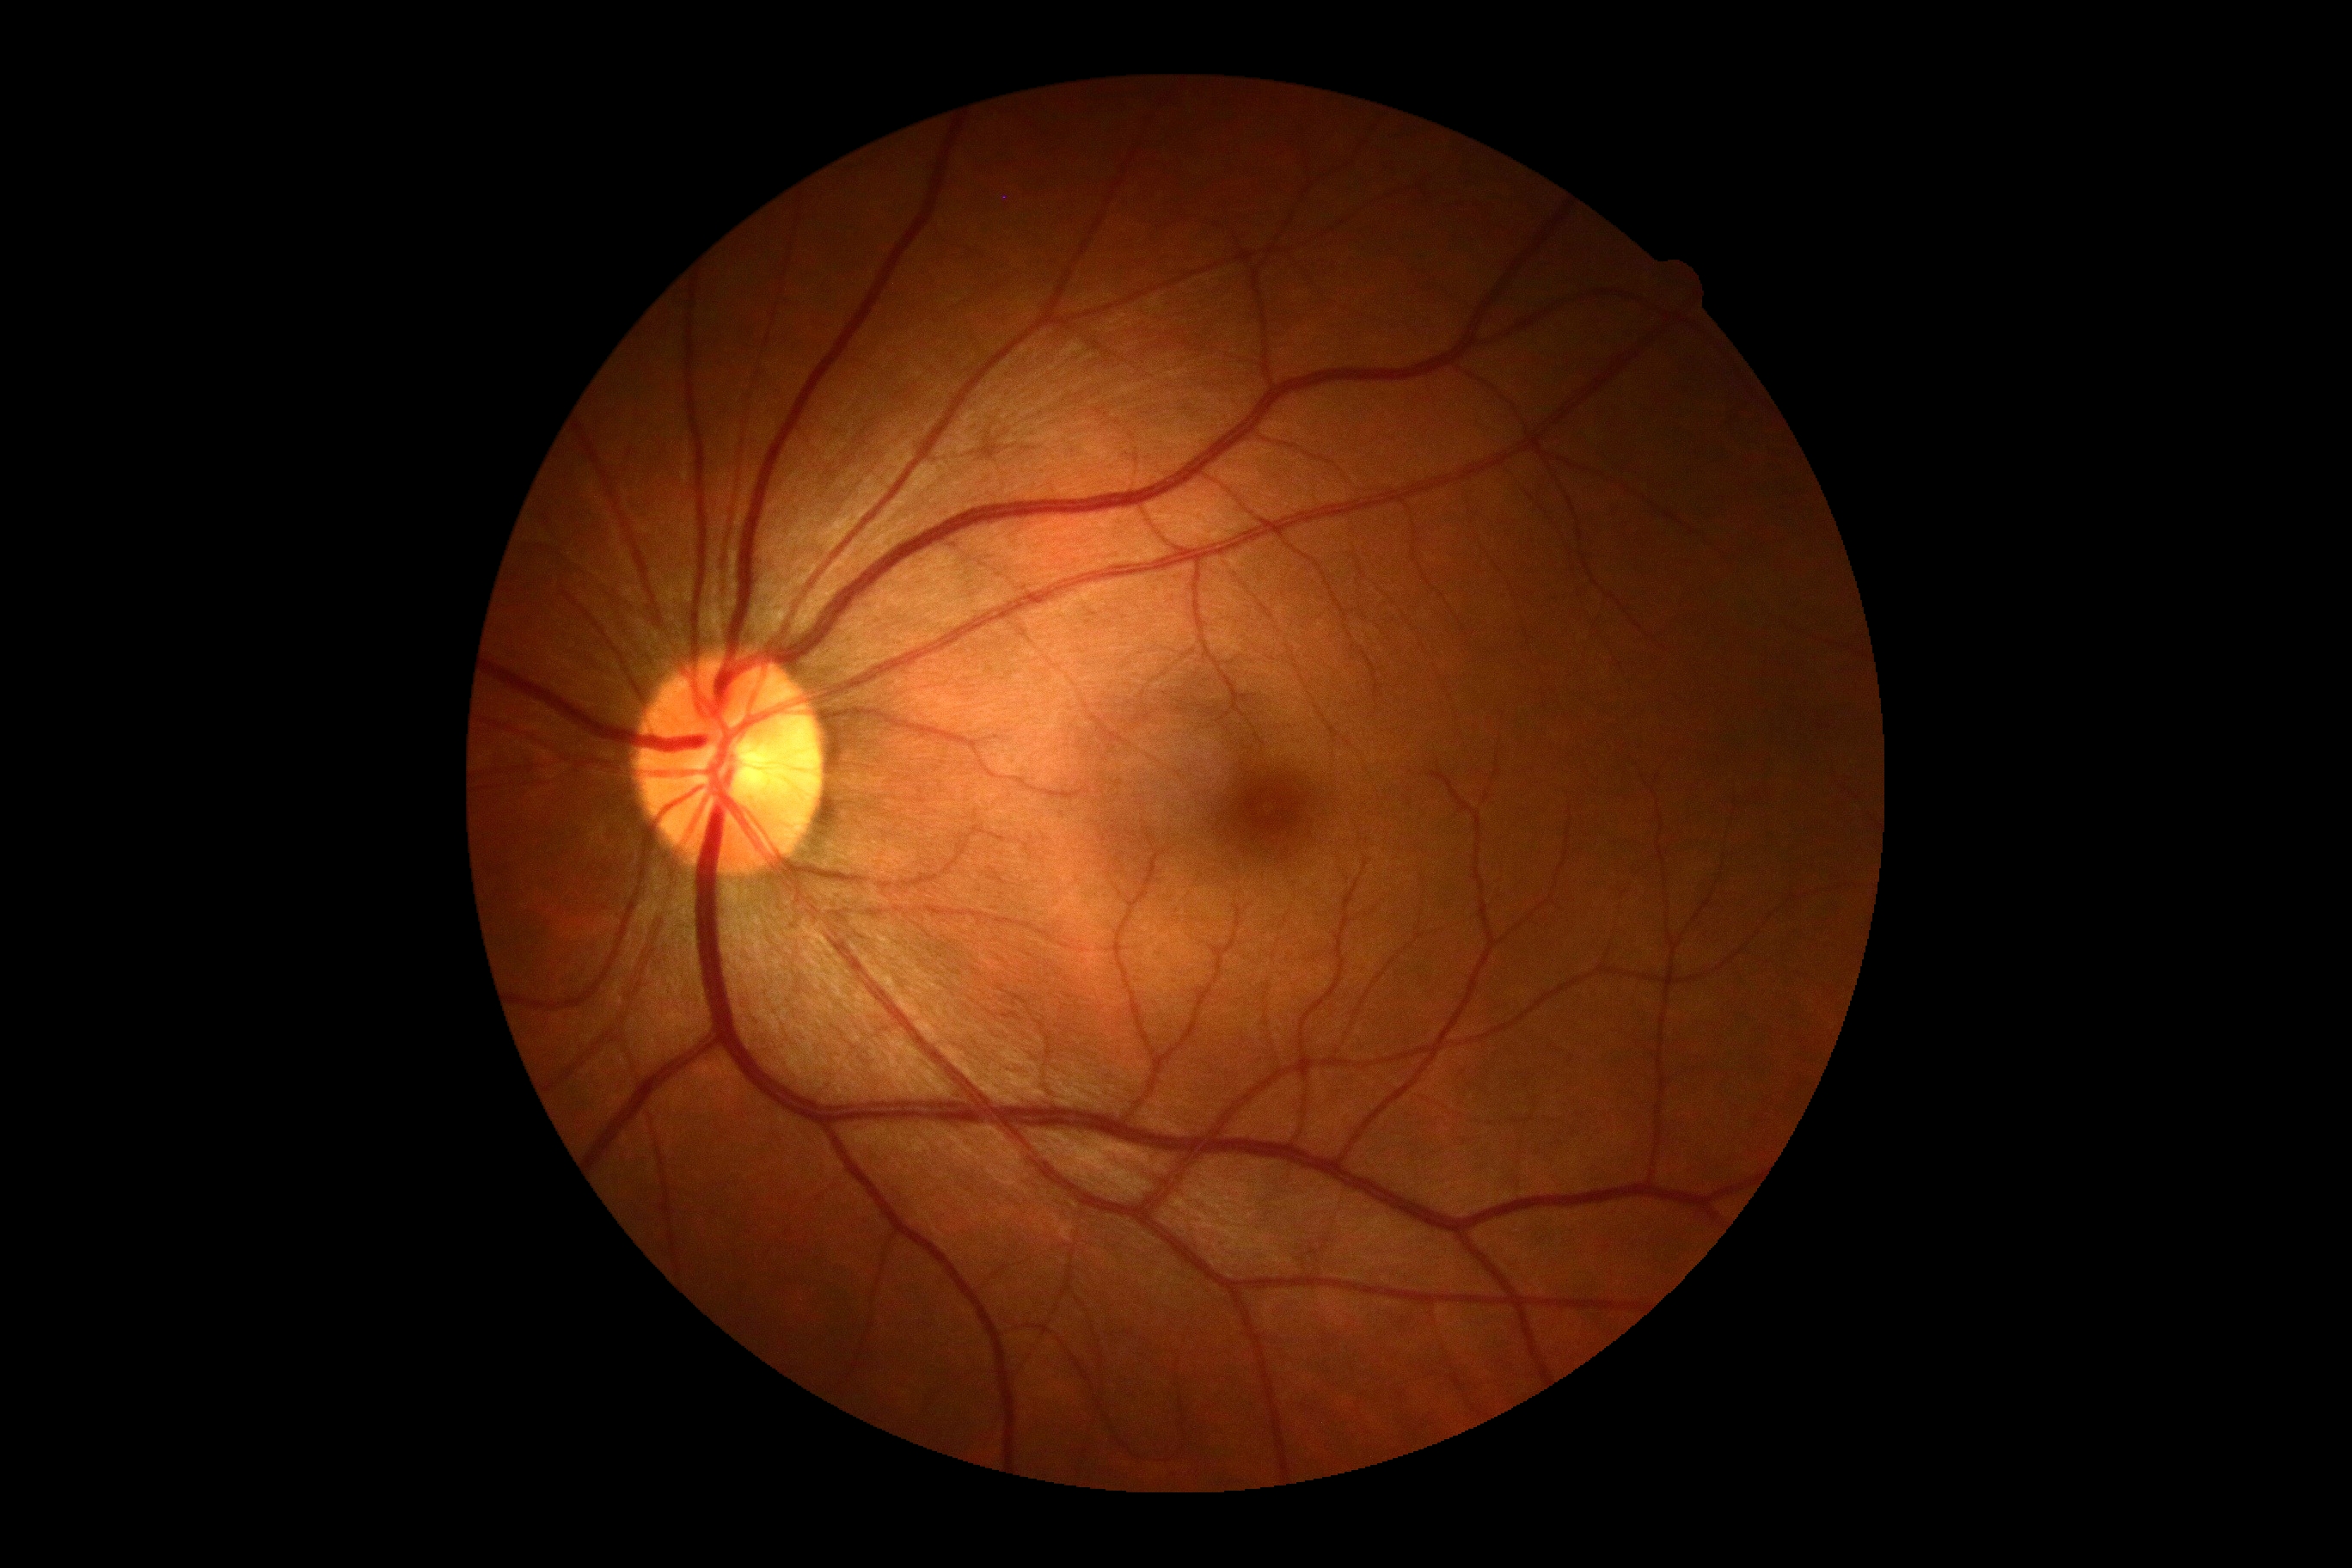

DR is 0/4. No apparent diabetic retinopathy.